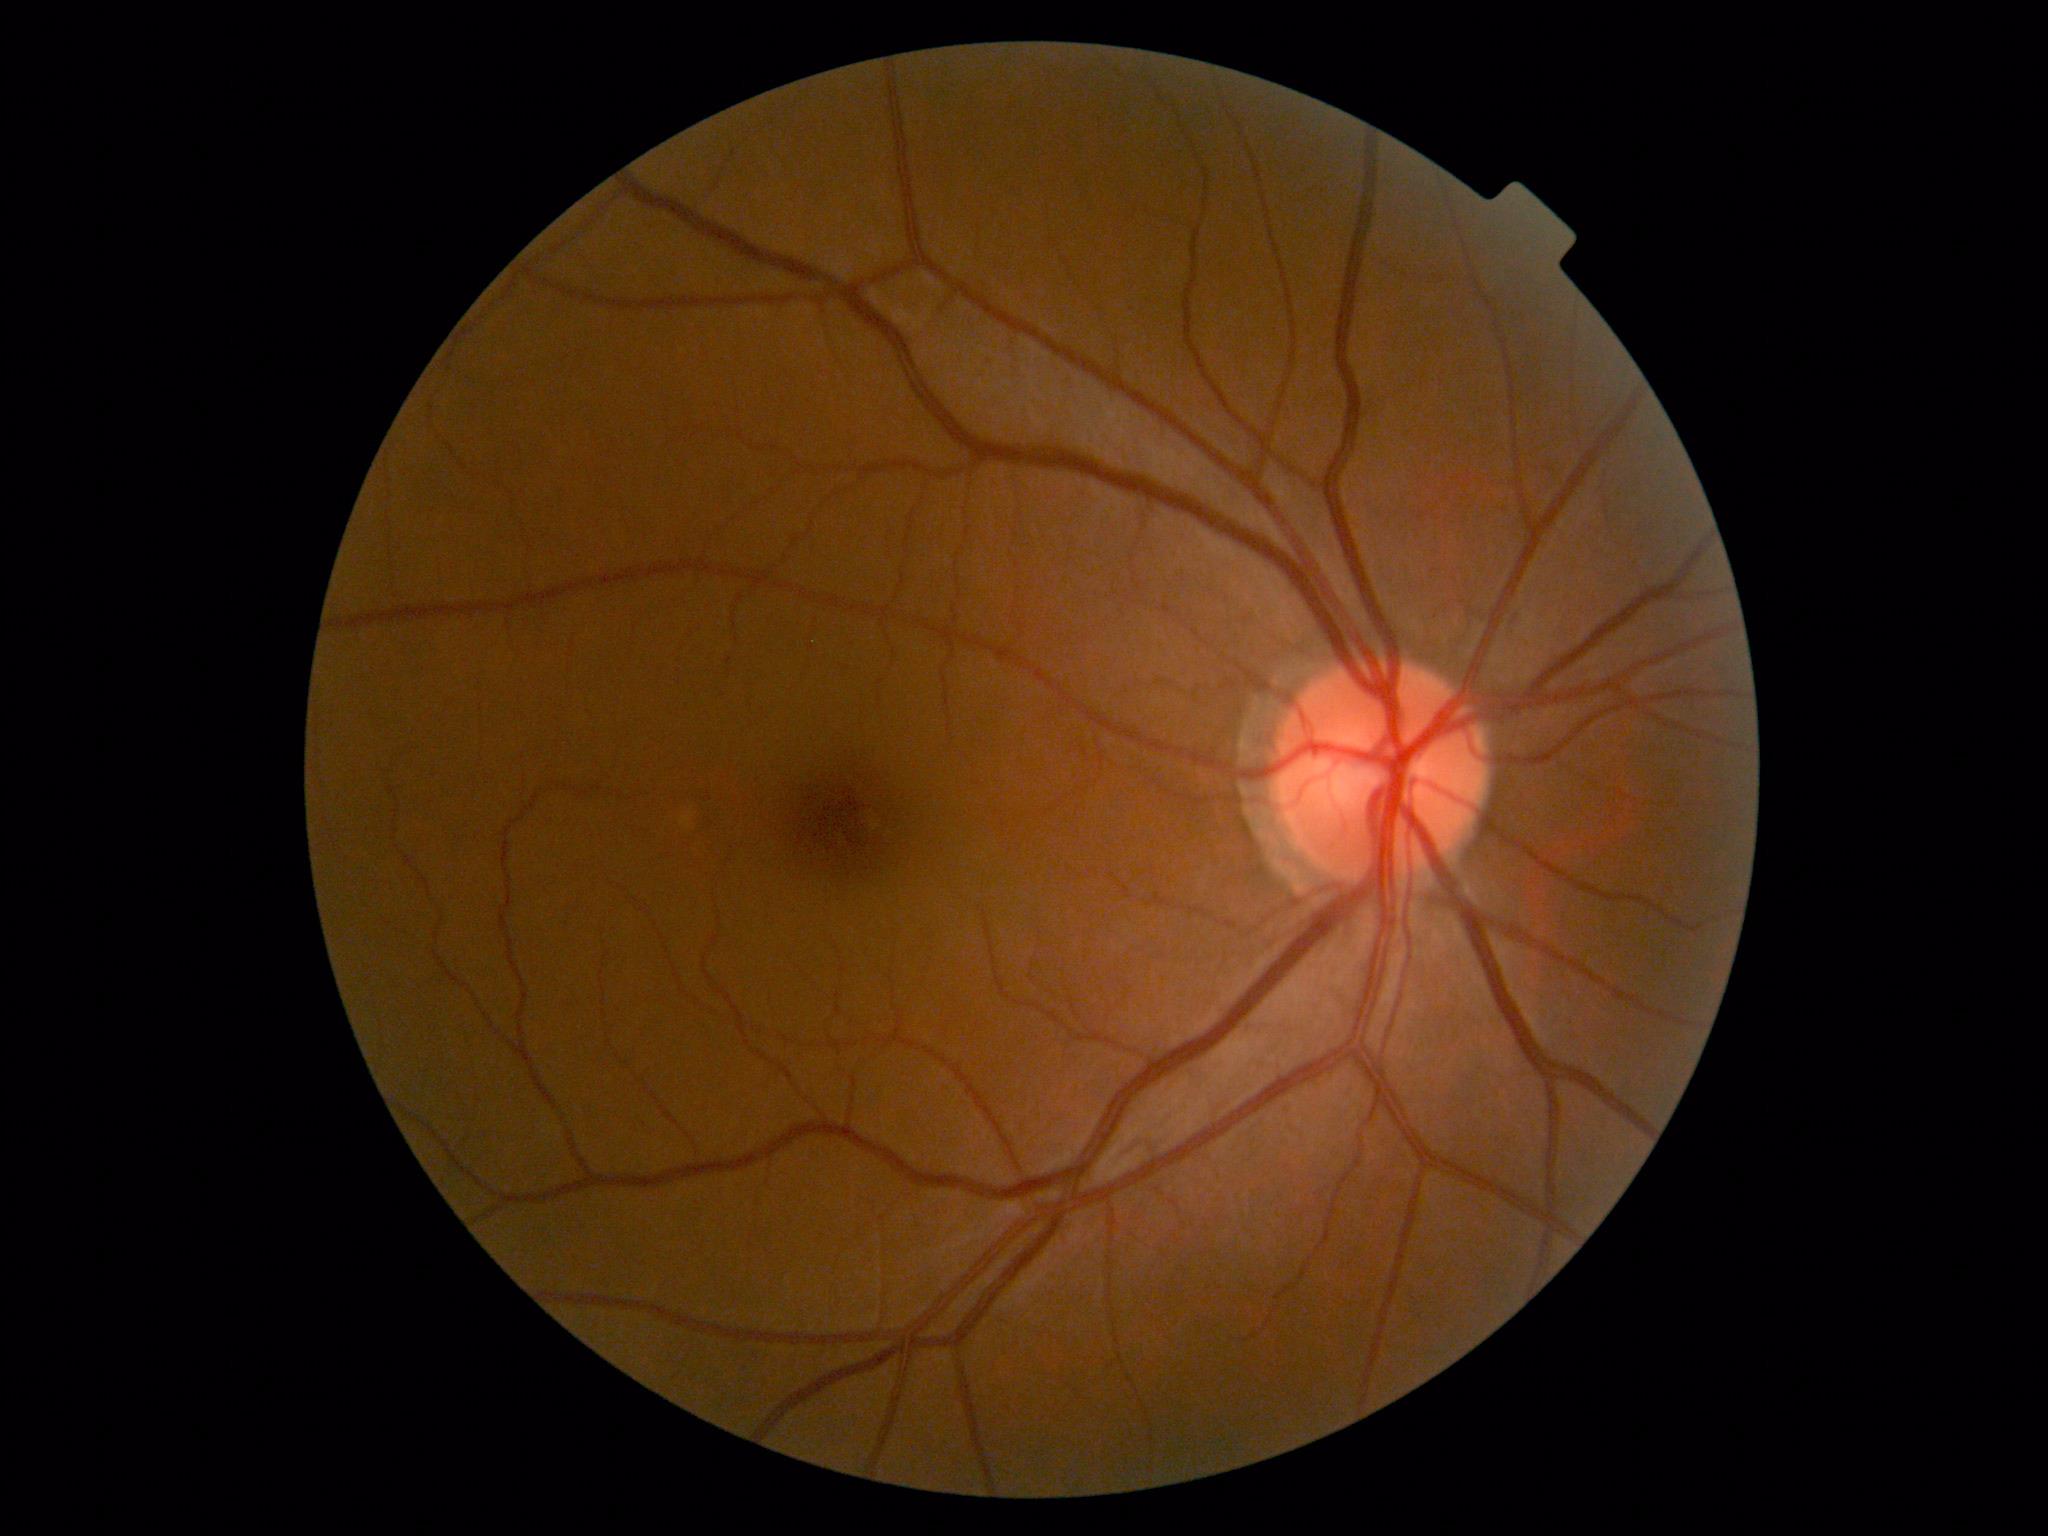

No diabetic retinal disease findings. DR: 0.